Image size 2212x1661: 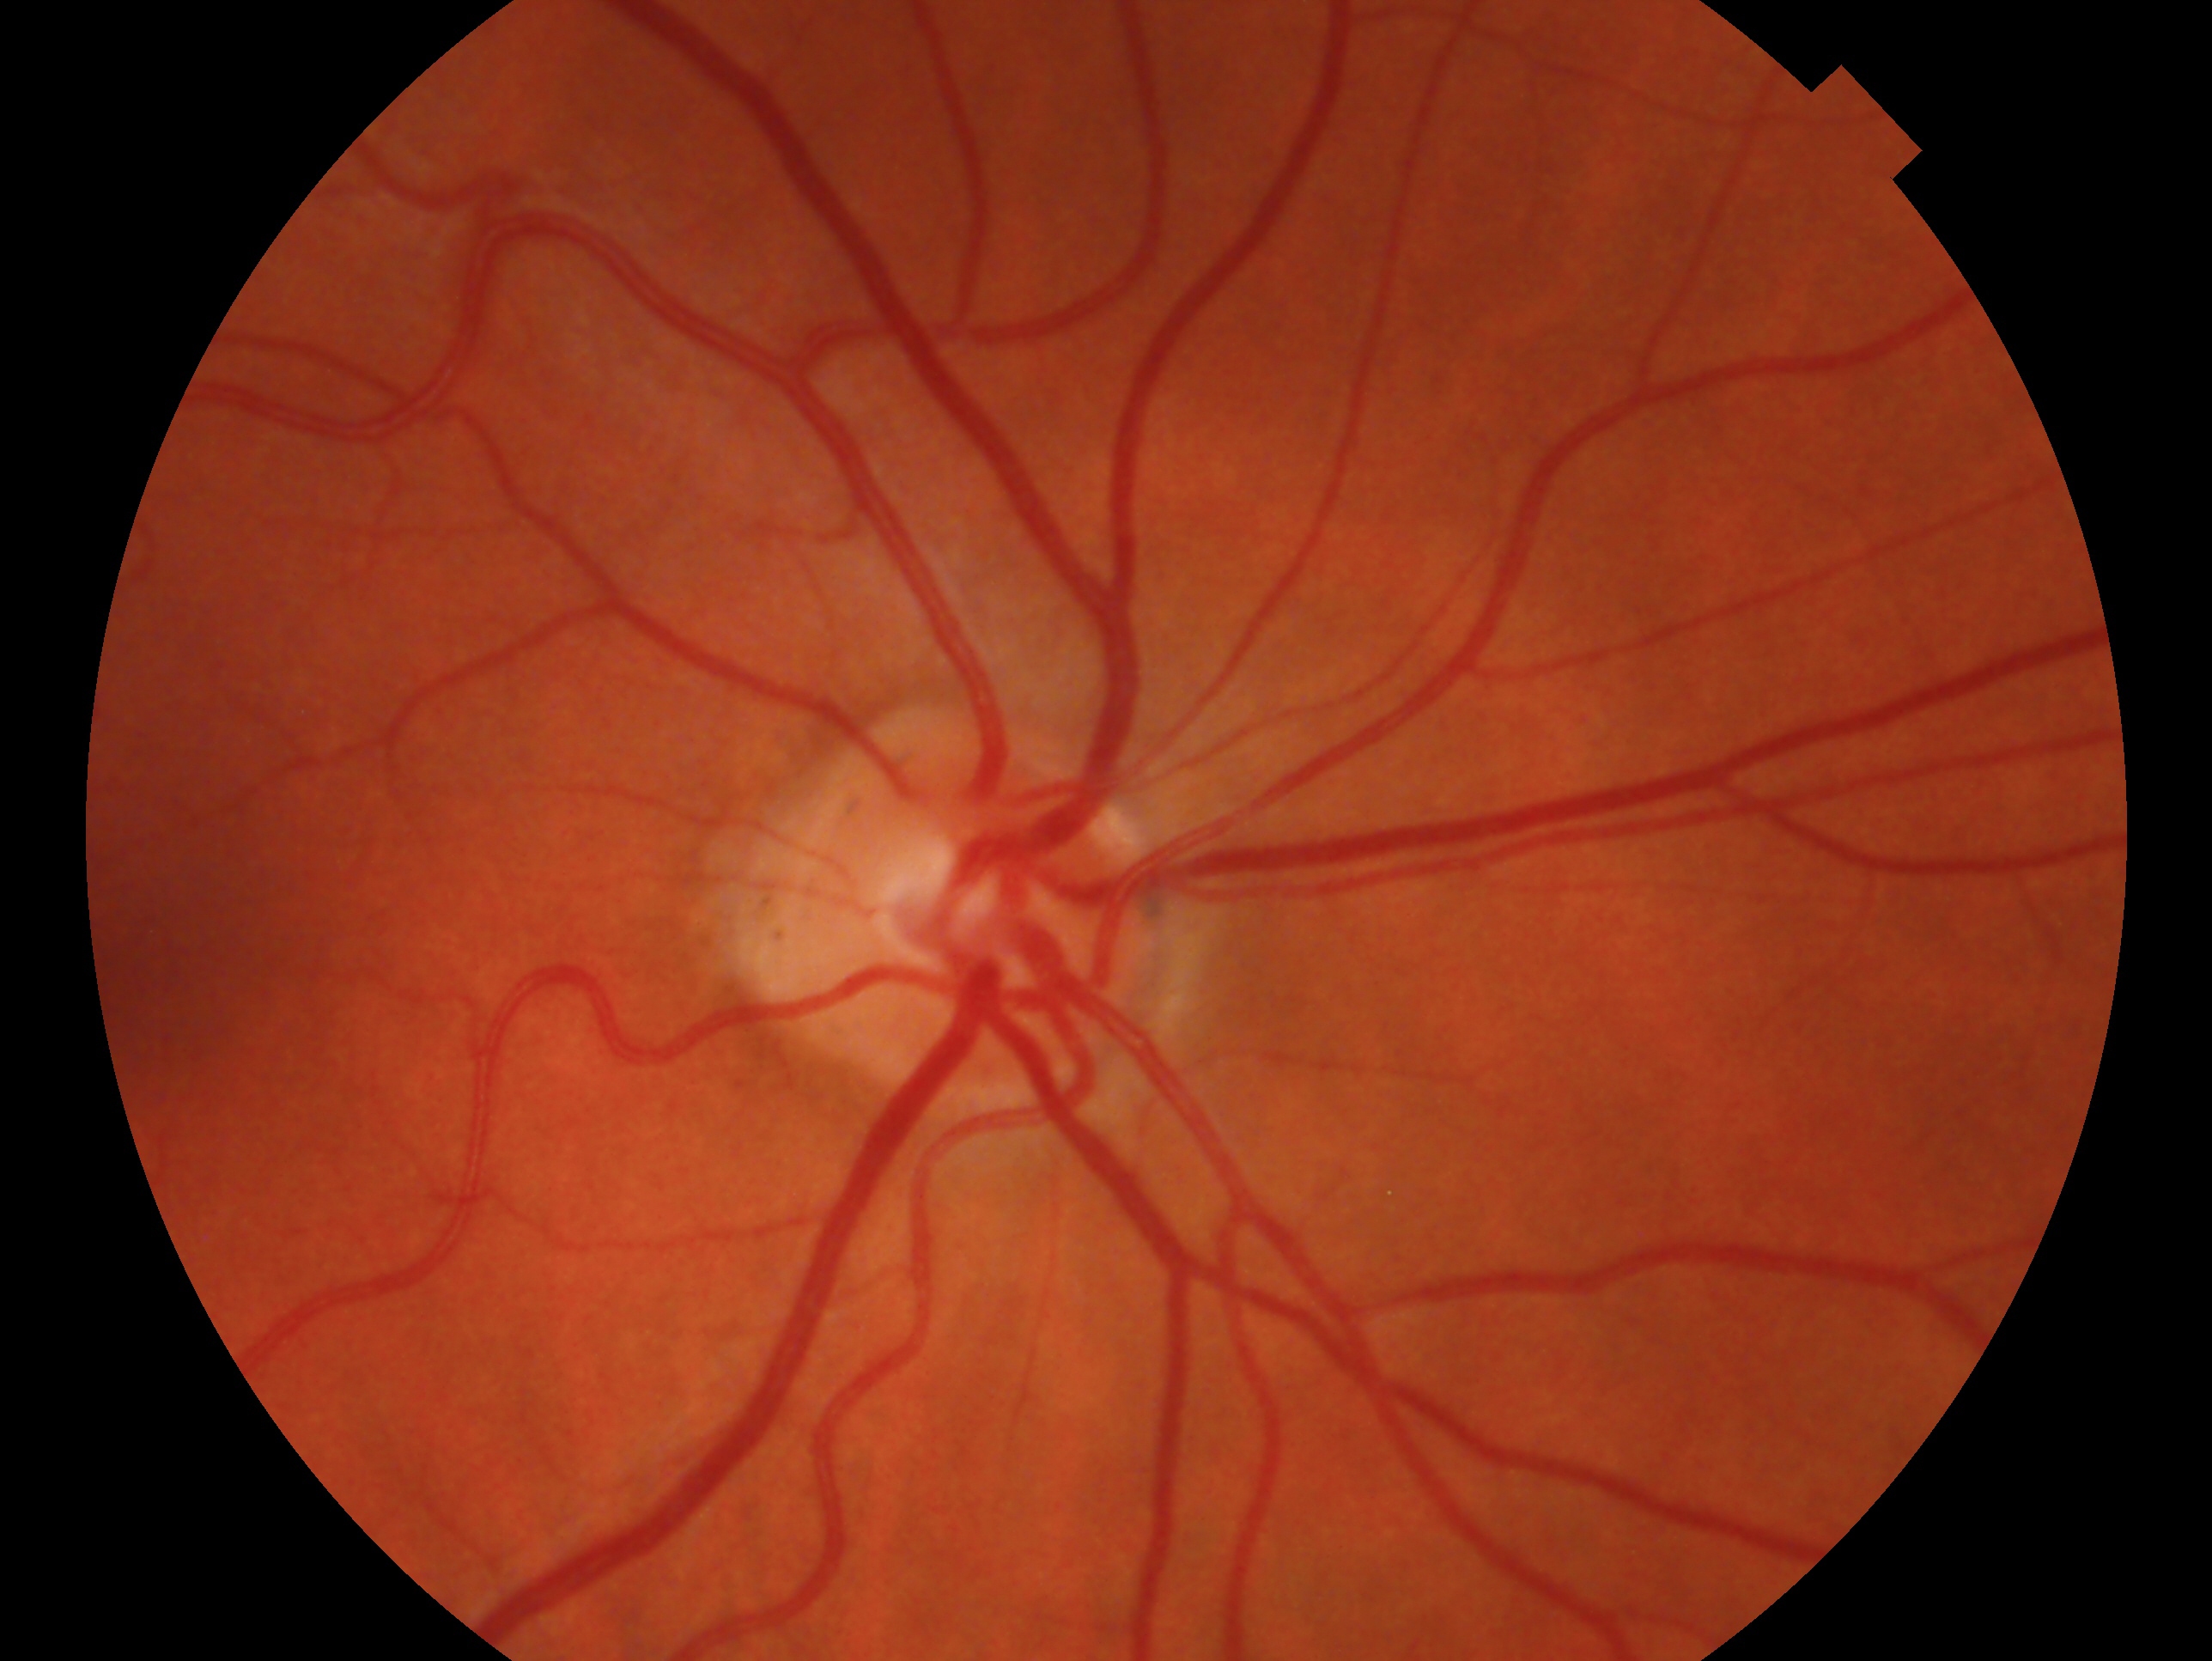
Findings:
– eye — OD
– impression — no glaucoma — no clinical evidence of glaucoma in this eye